Color fundus image: 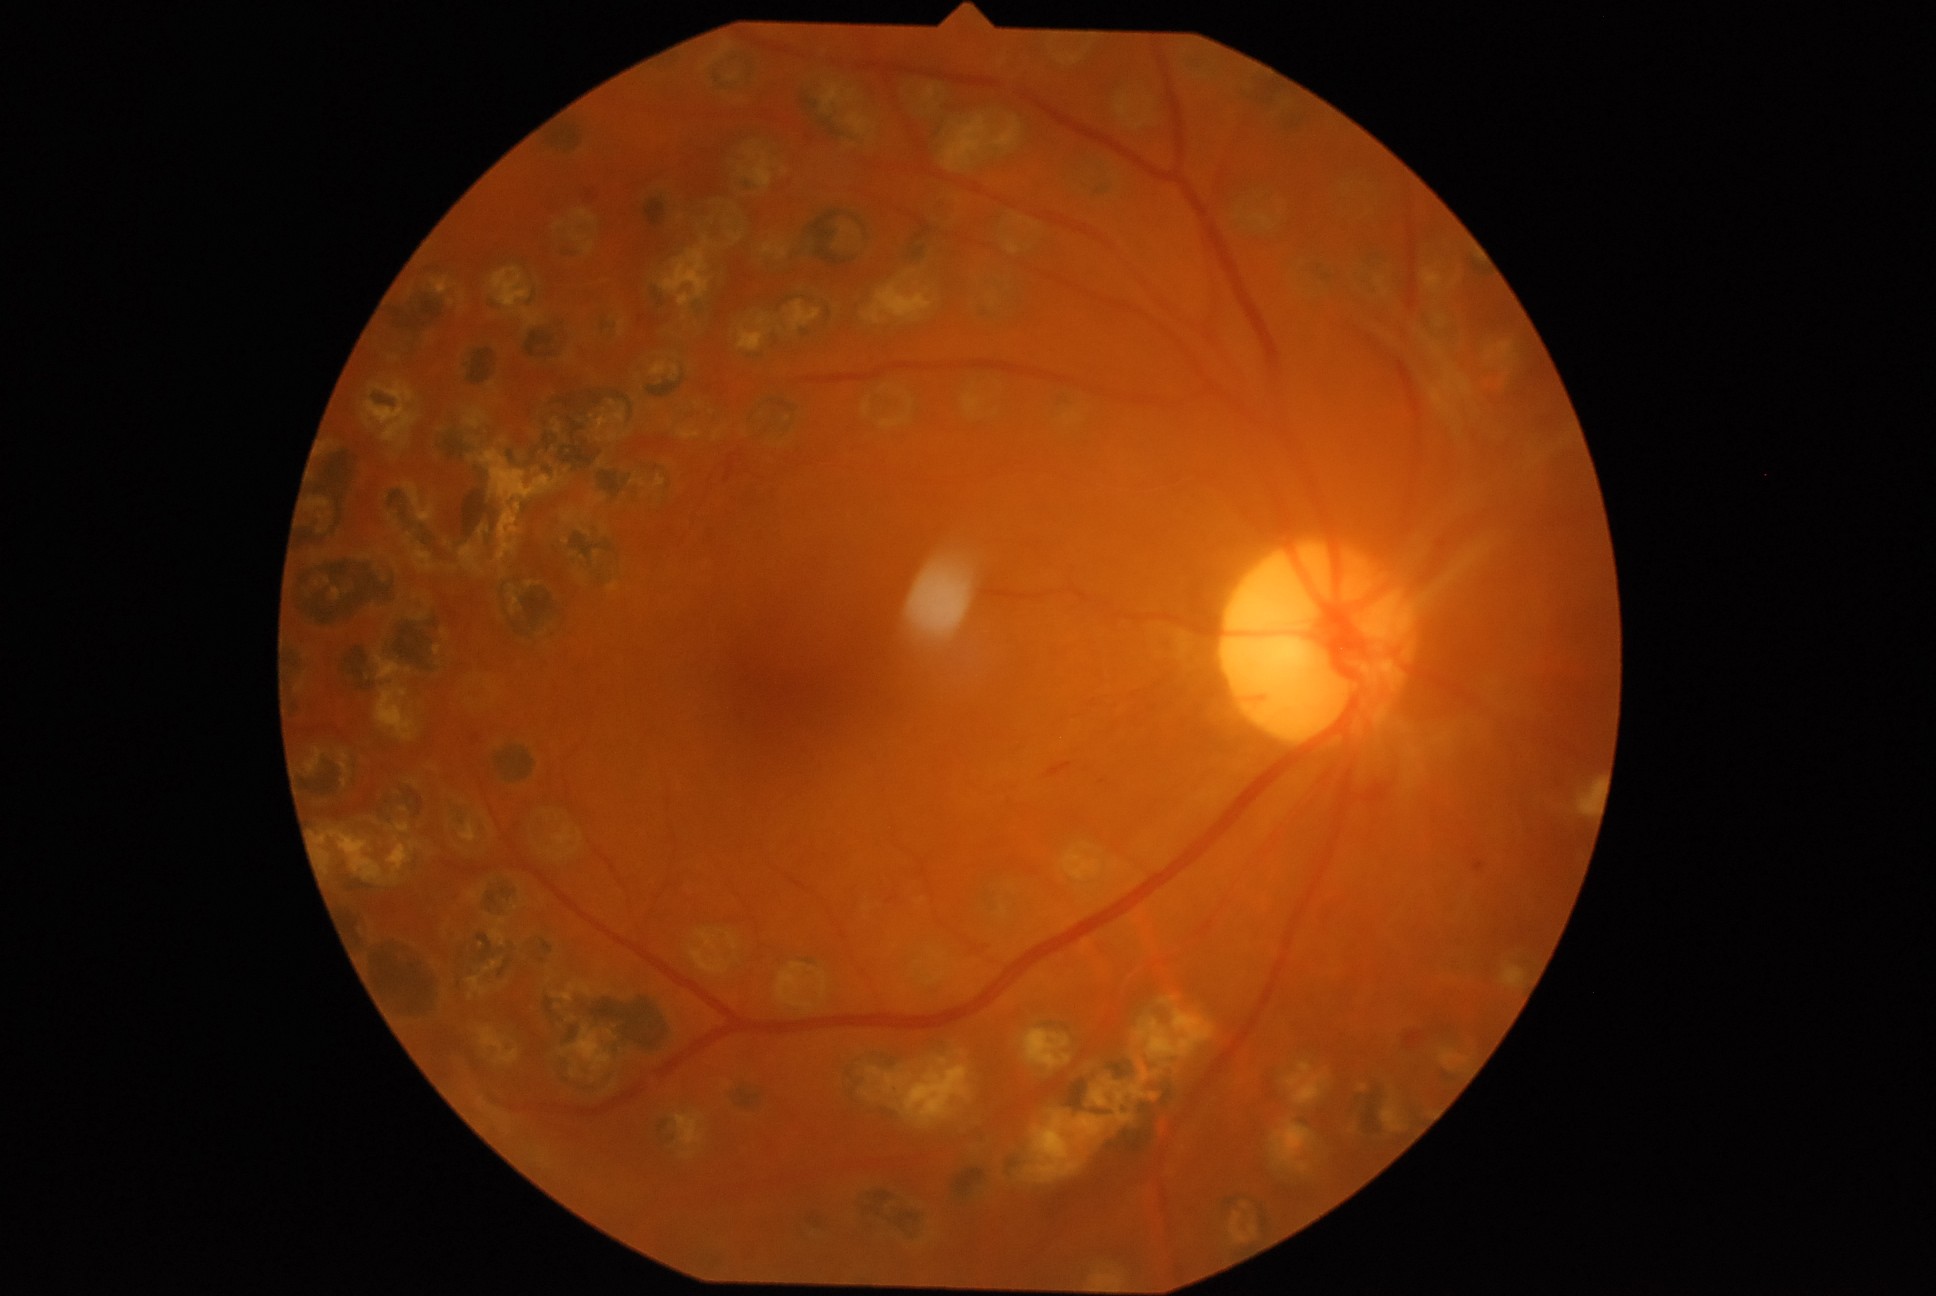

Findings:
* DR severity: 4